CFP; 43 years old; intraocular pressure (IOP): 15 mmHg
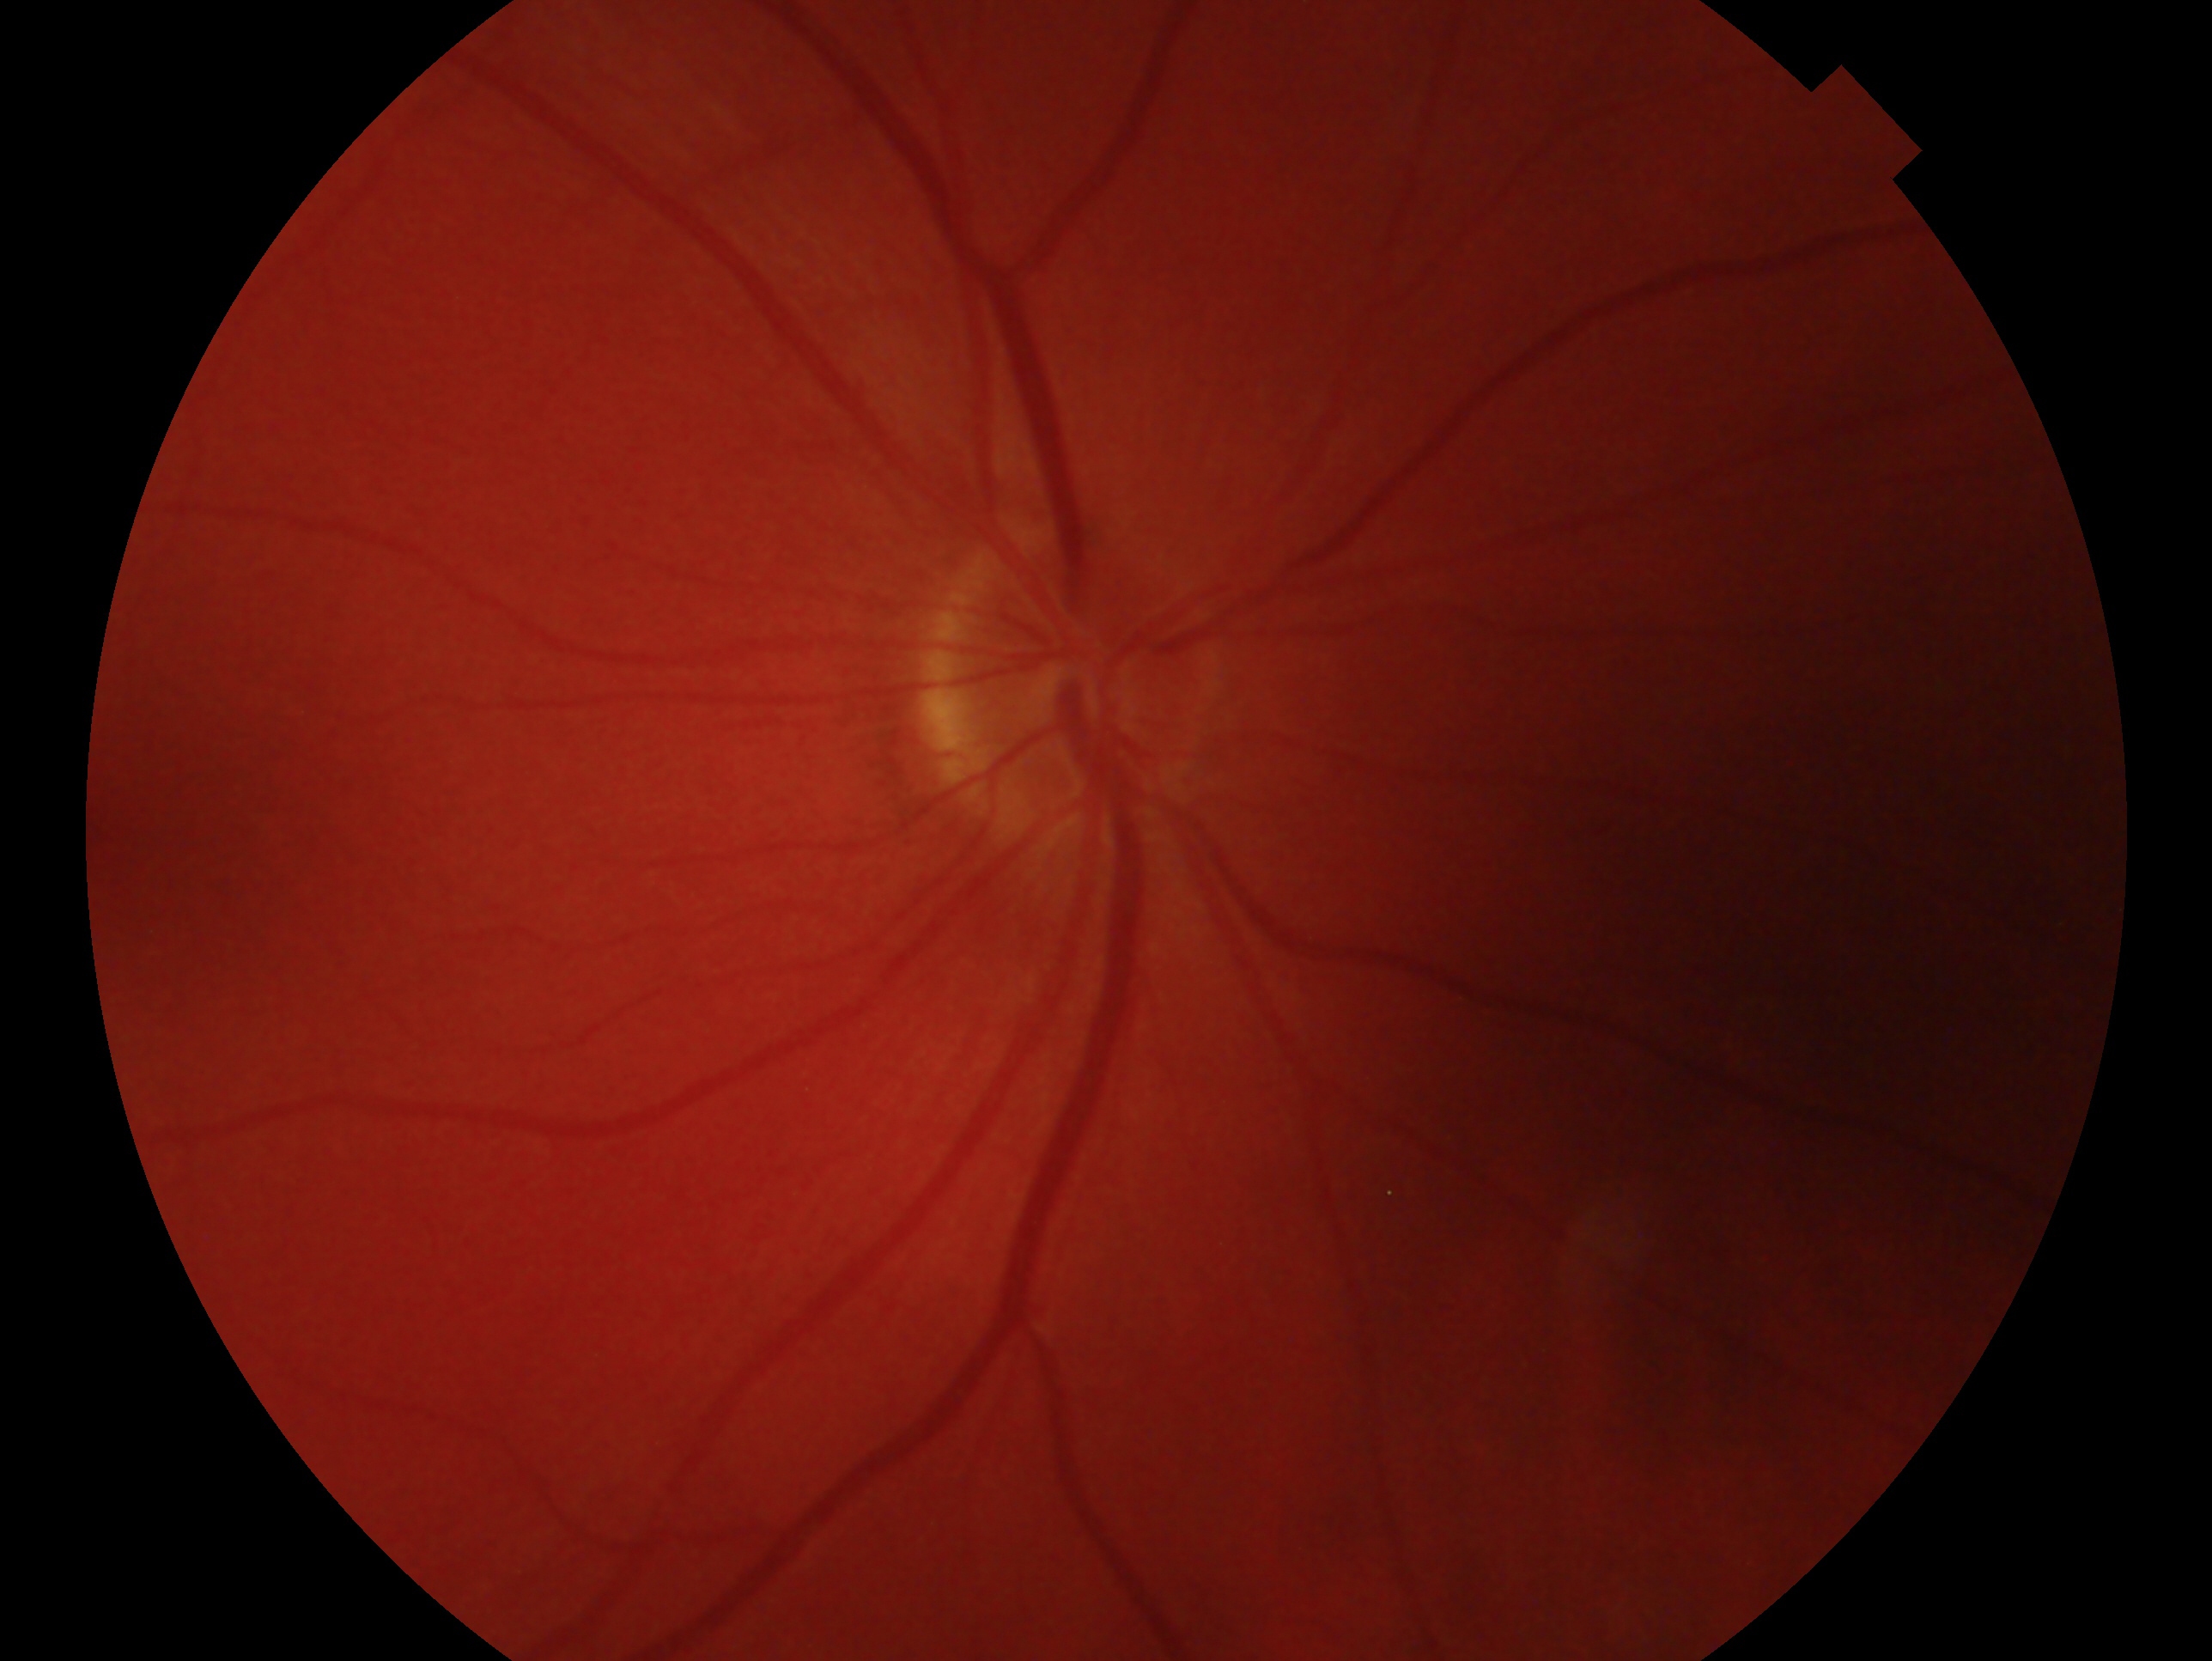

laterality=right eye
assessment=no glaucomatous findings